NIDEK AFC-230.
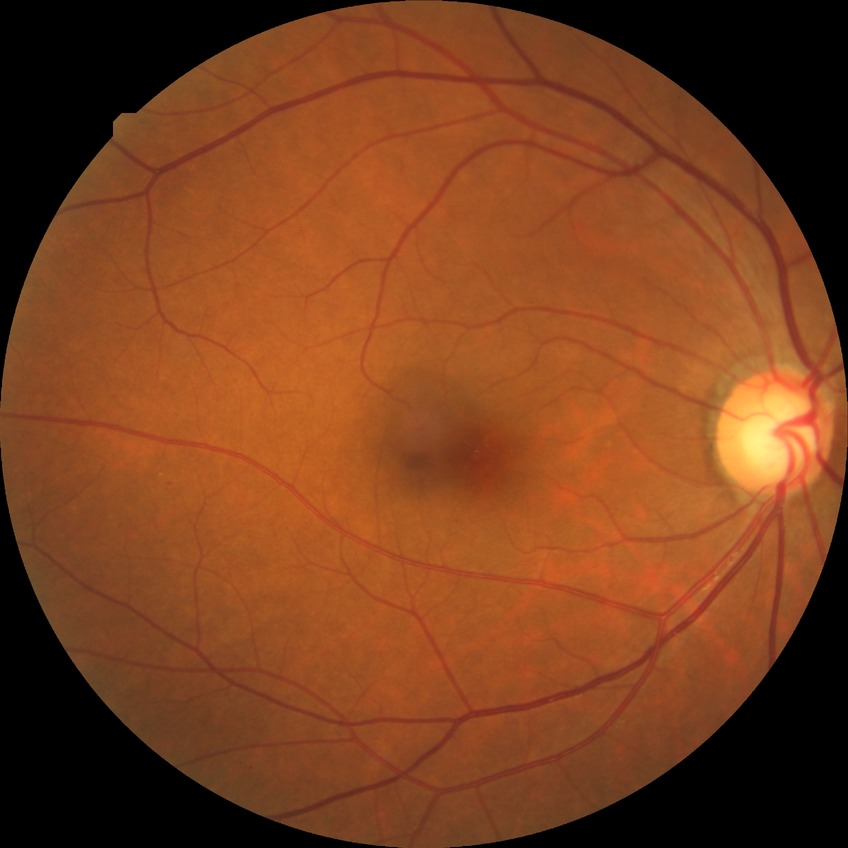

Diabetic retinopathy (DR) is simple diabetic retinopathy (SDR).